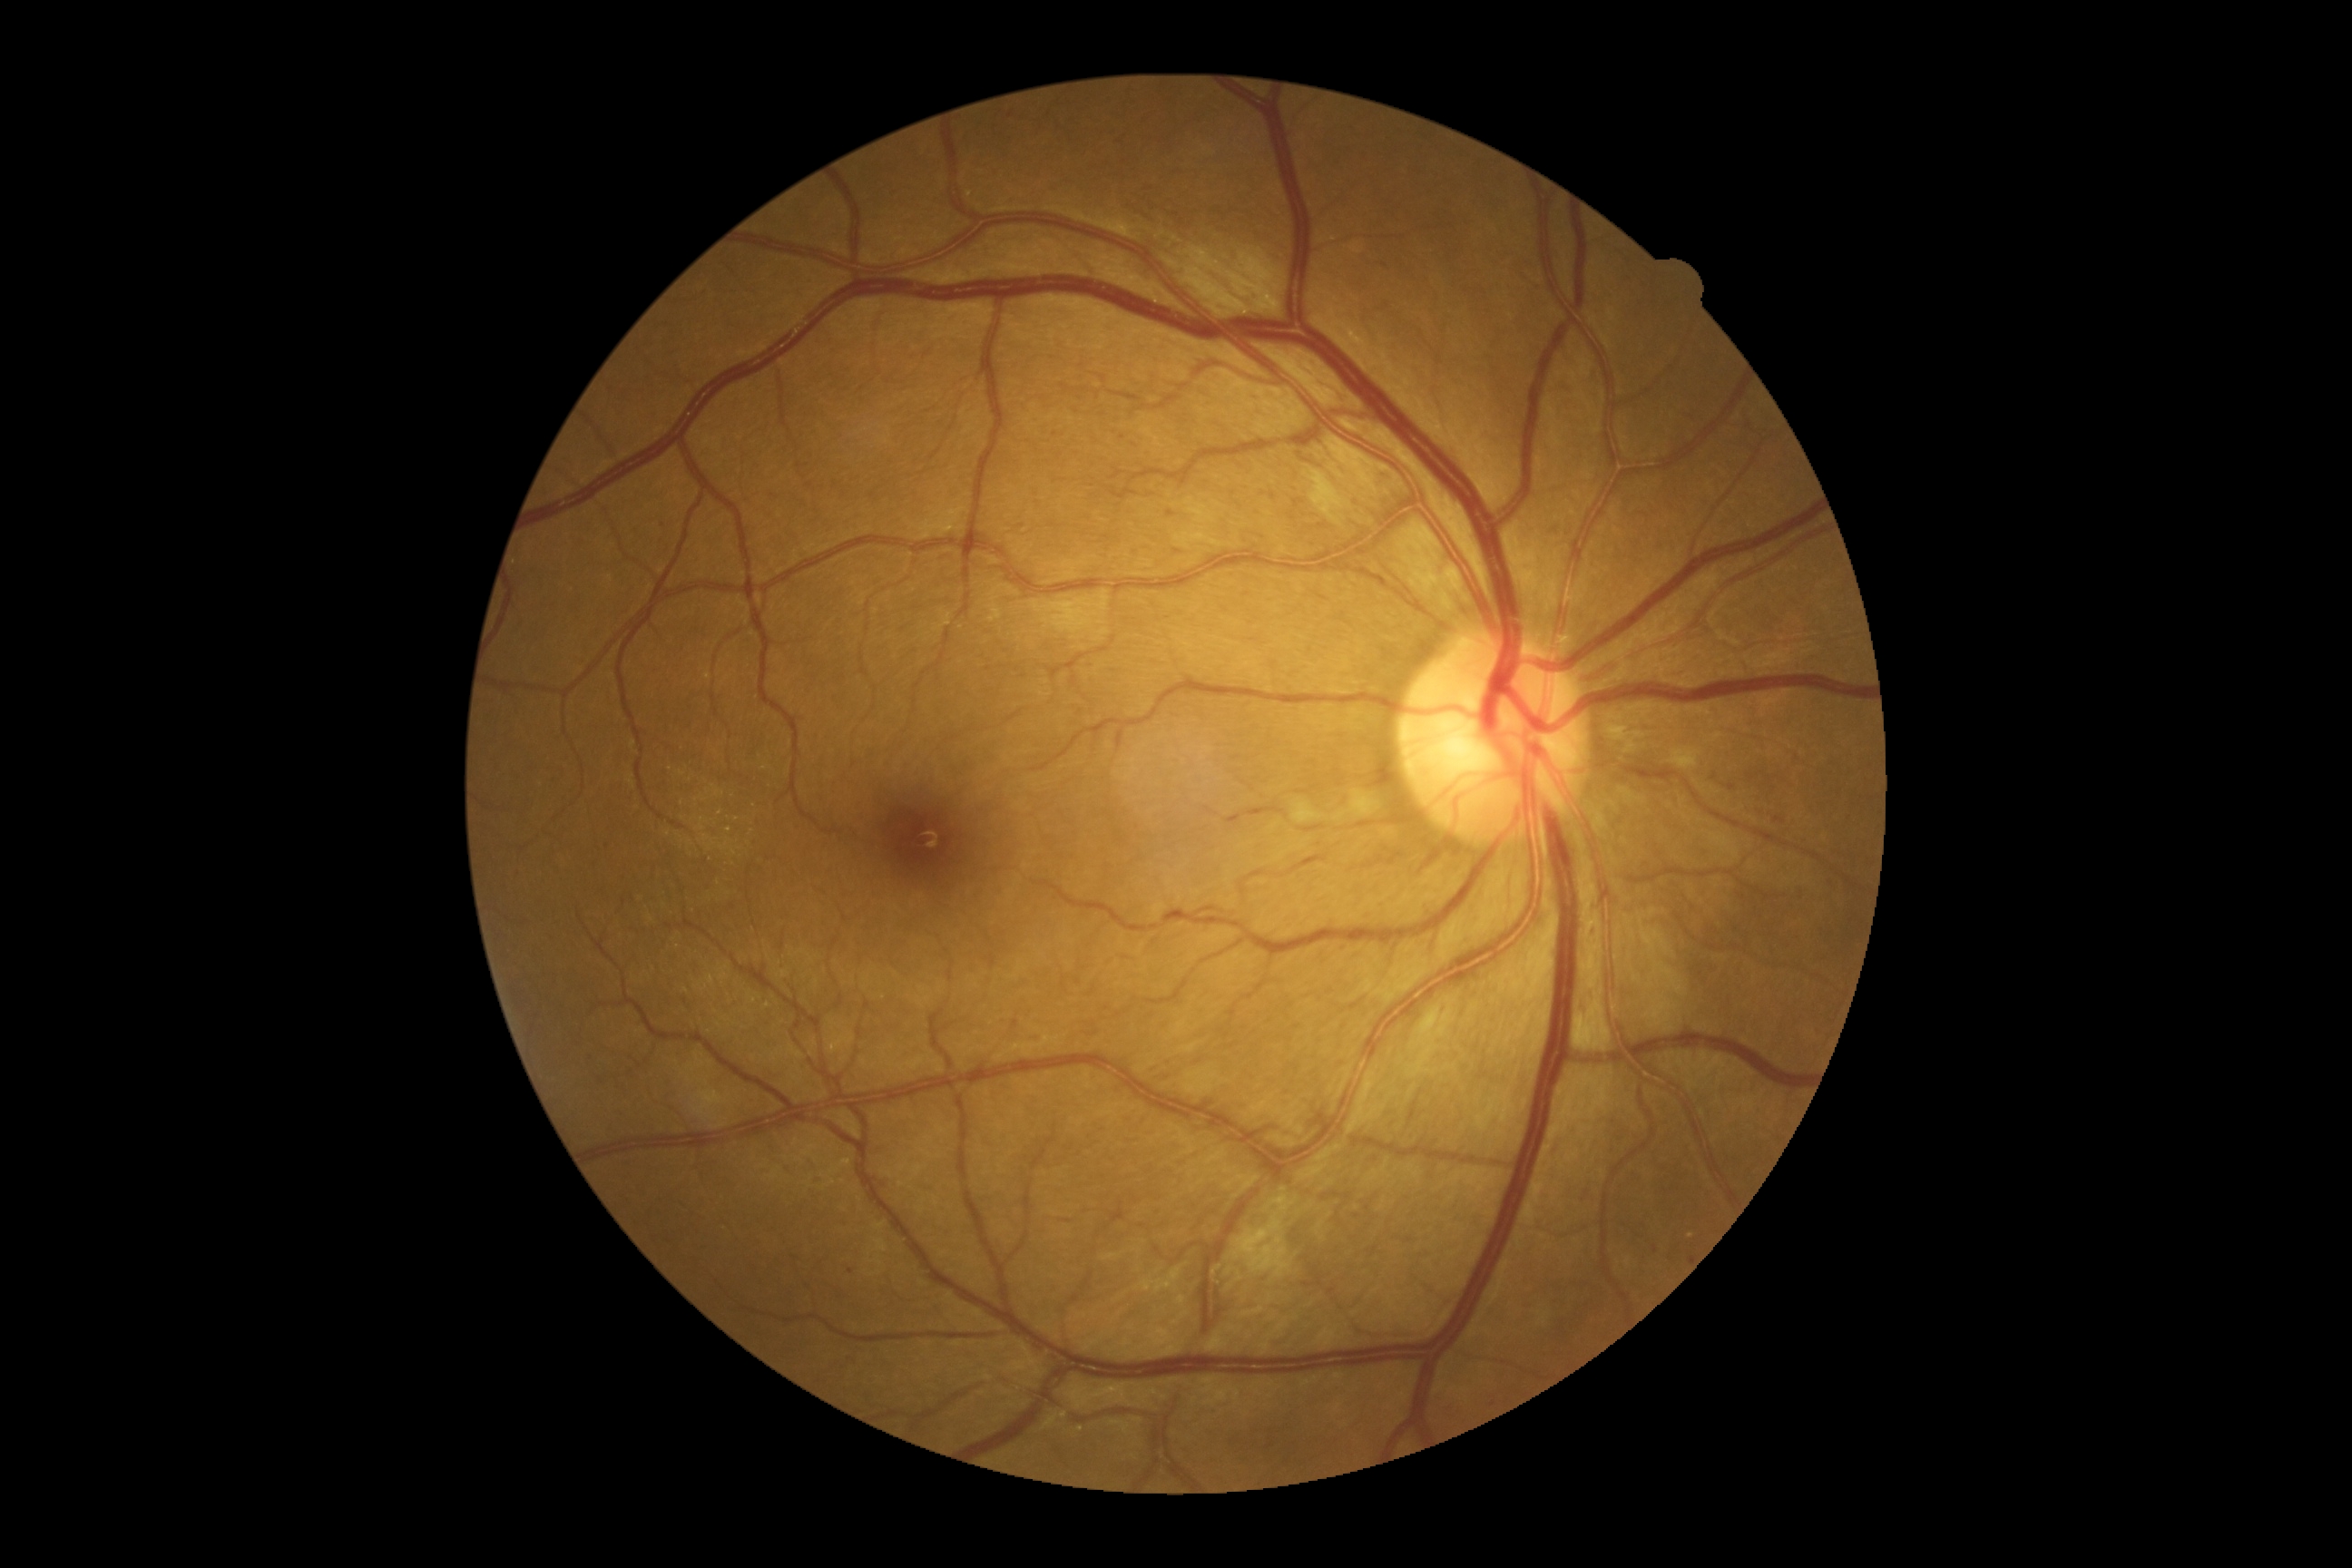
Disease class: non-proliferative diabetic retinopathy. DR severity is 2/4.